2048x1536px, color fundus image, 45° field of view:
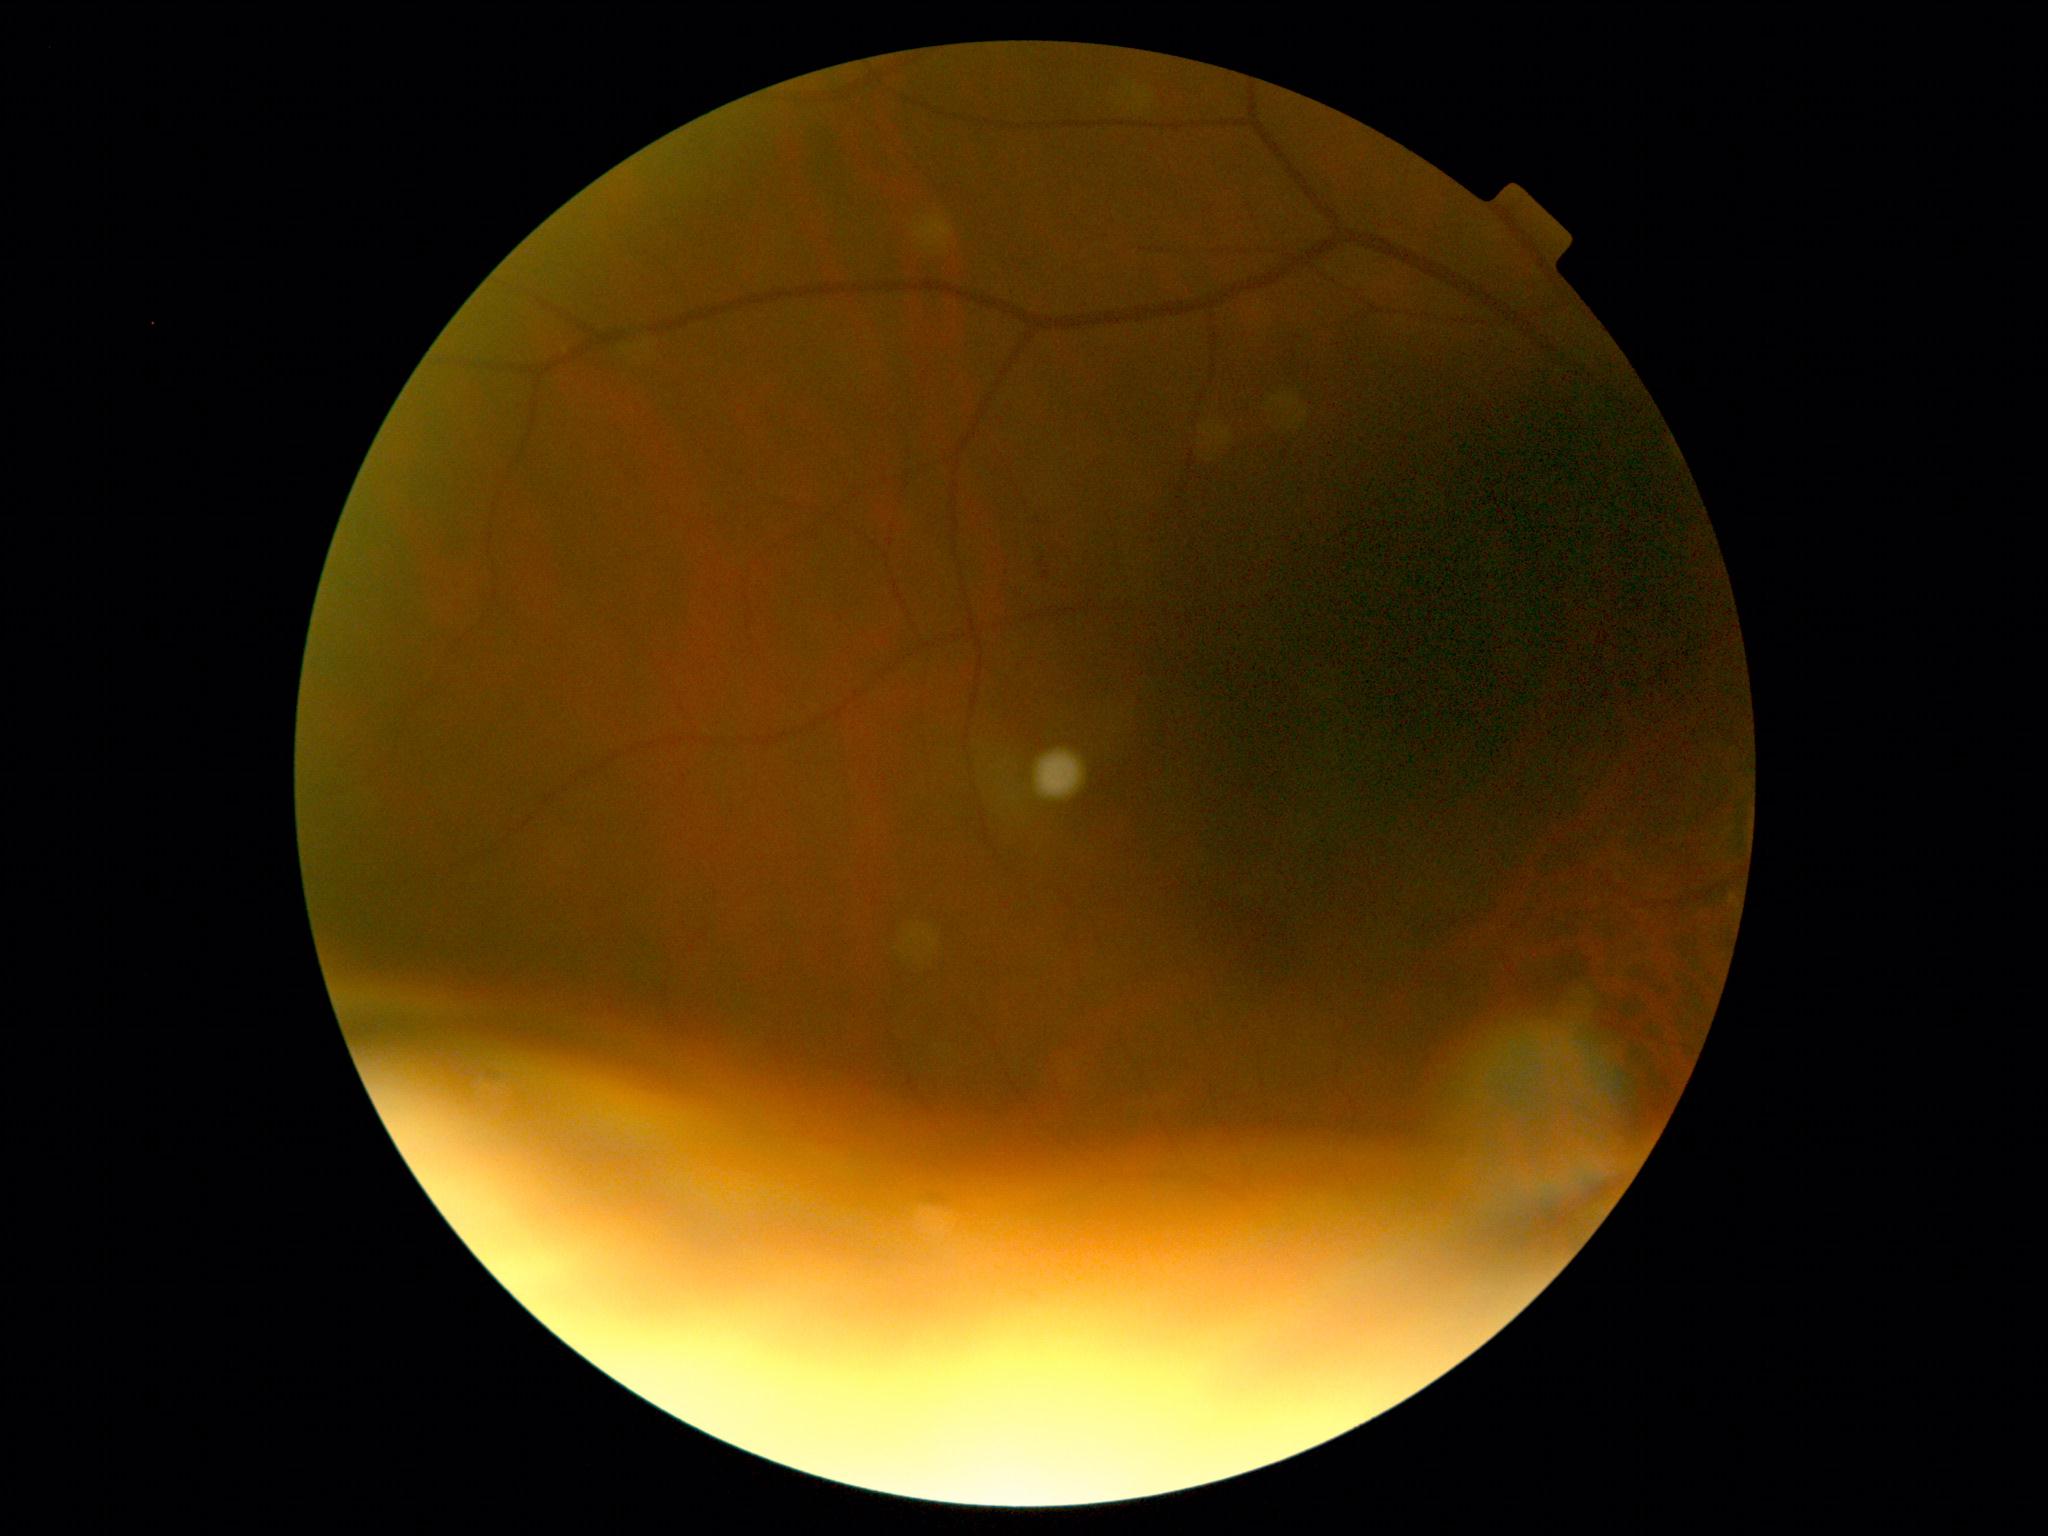 DR severity is ungradable due to poor image quality.